240x240px. Nidek AFC-330:
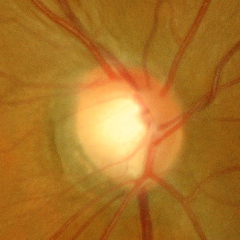
There is evidence of early-stage glaucoma.